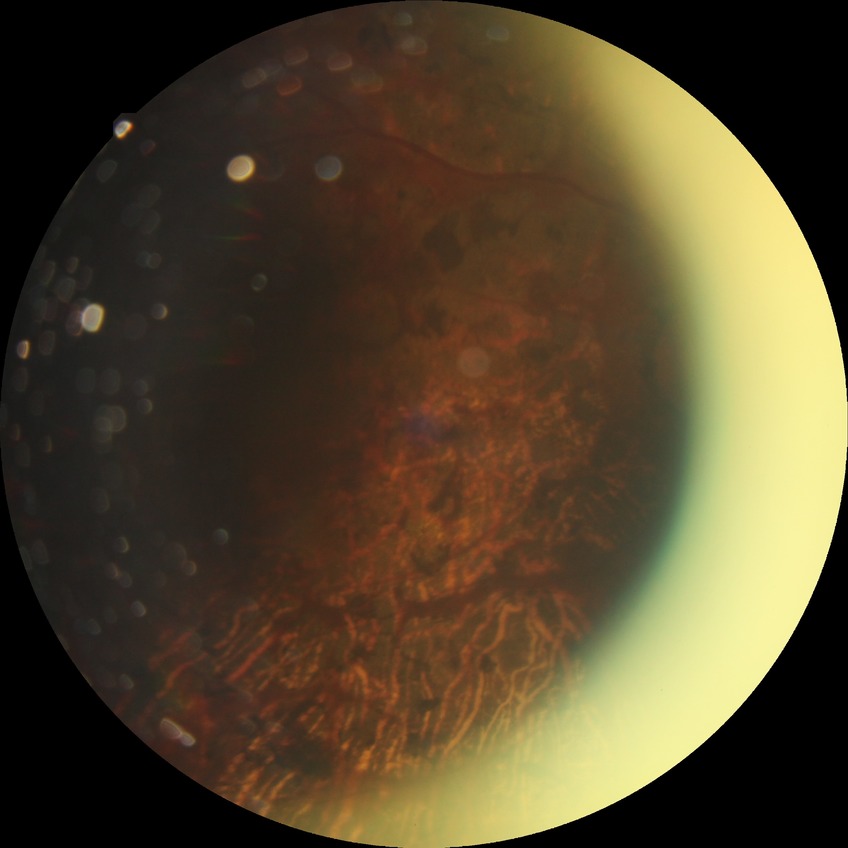

diabetic retinopathy (DR) = PDR (proliferative diabetic retinopathy)